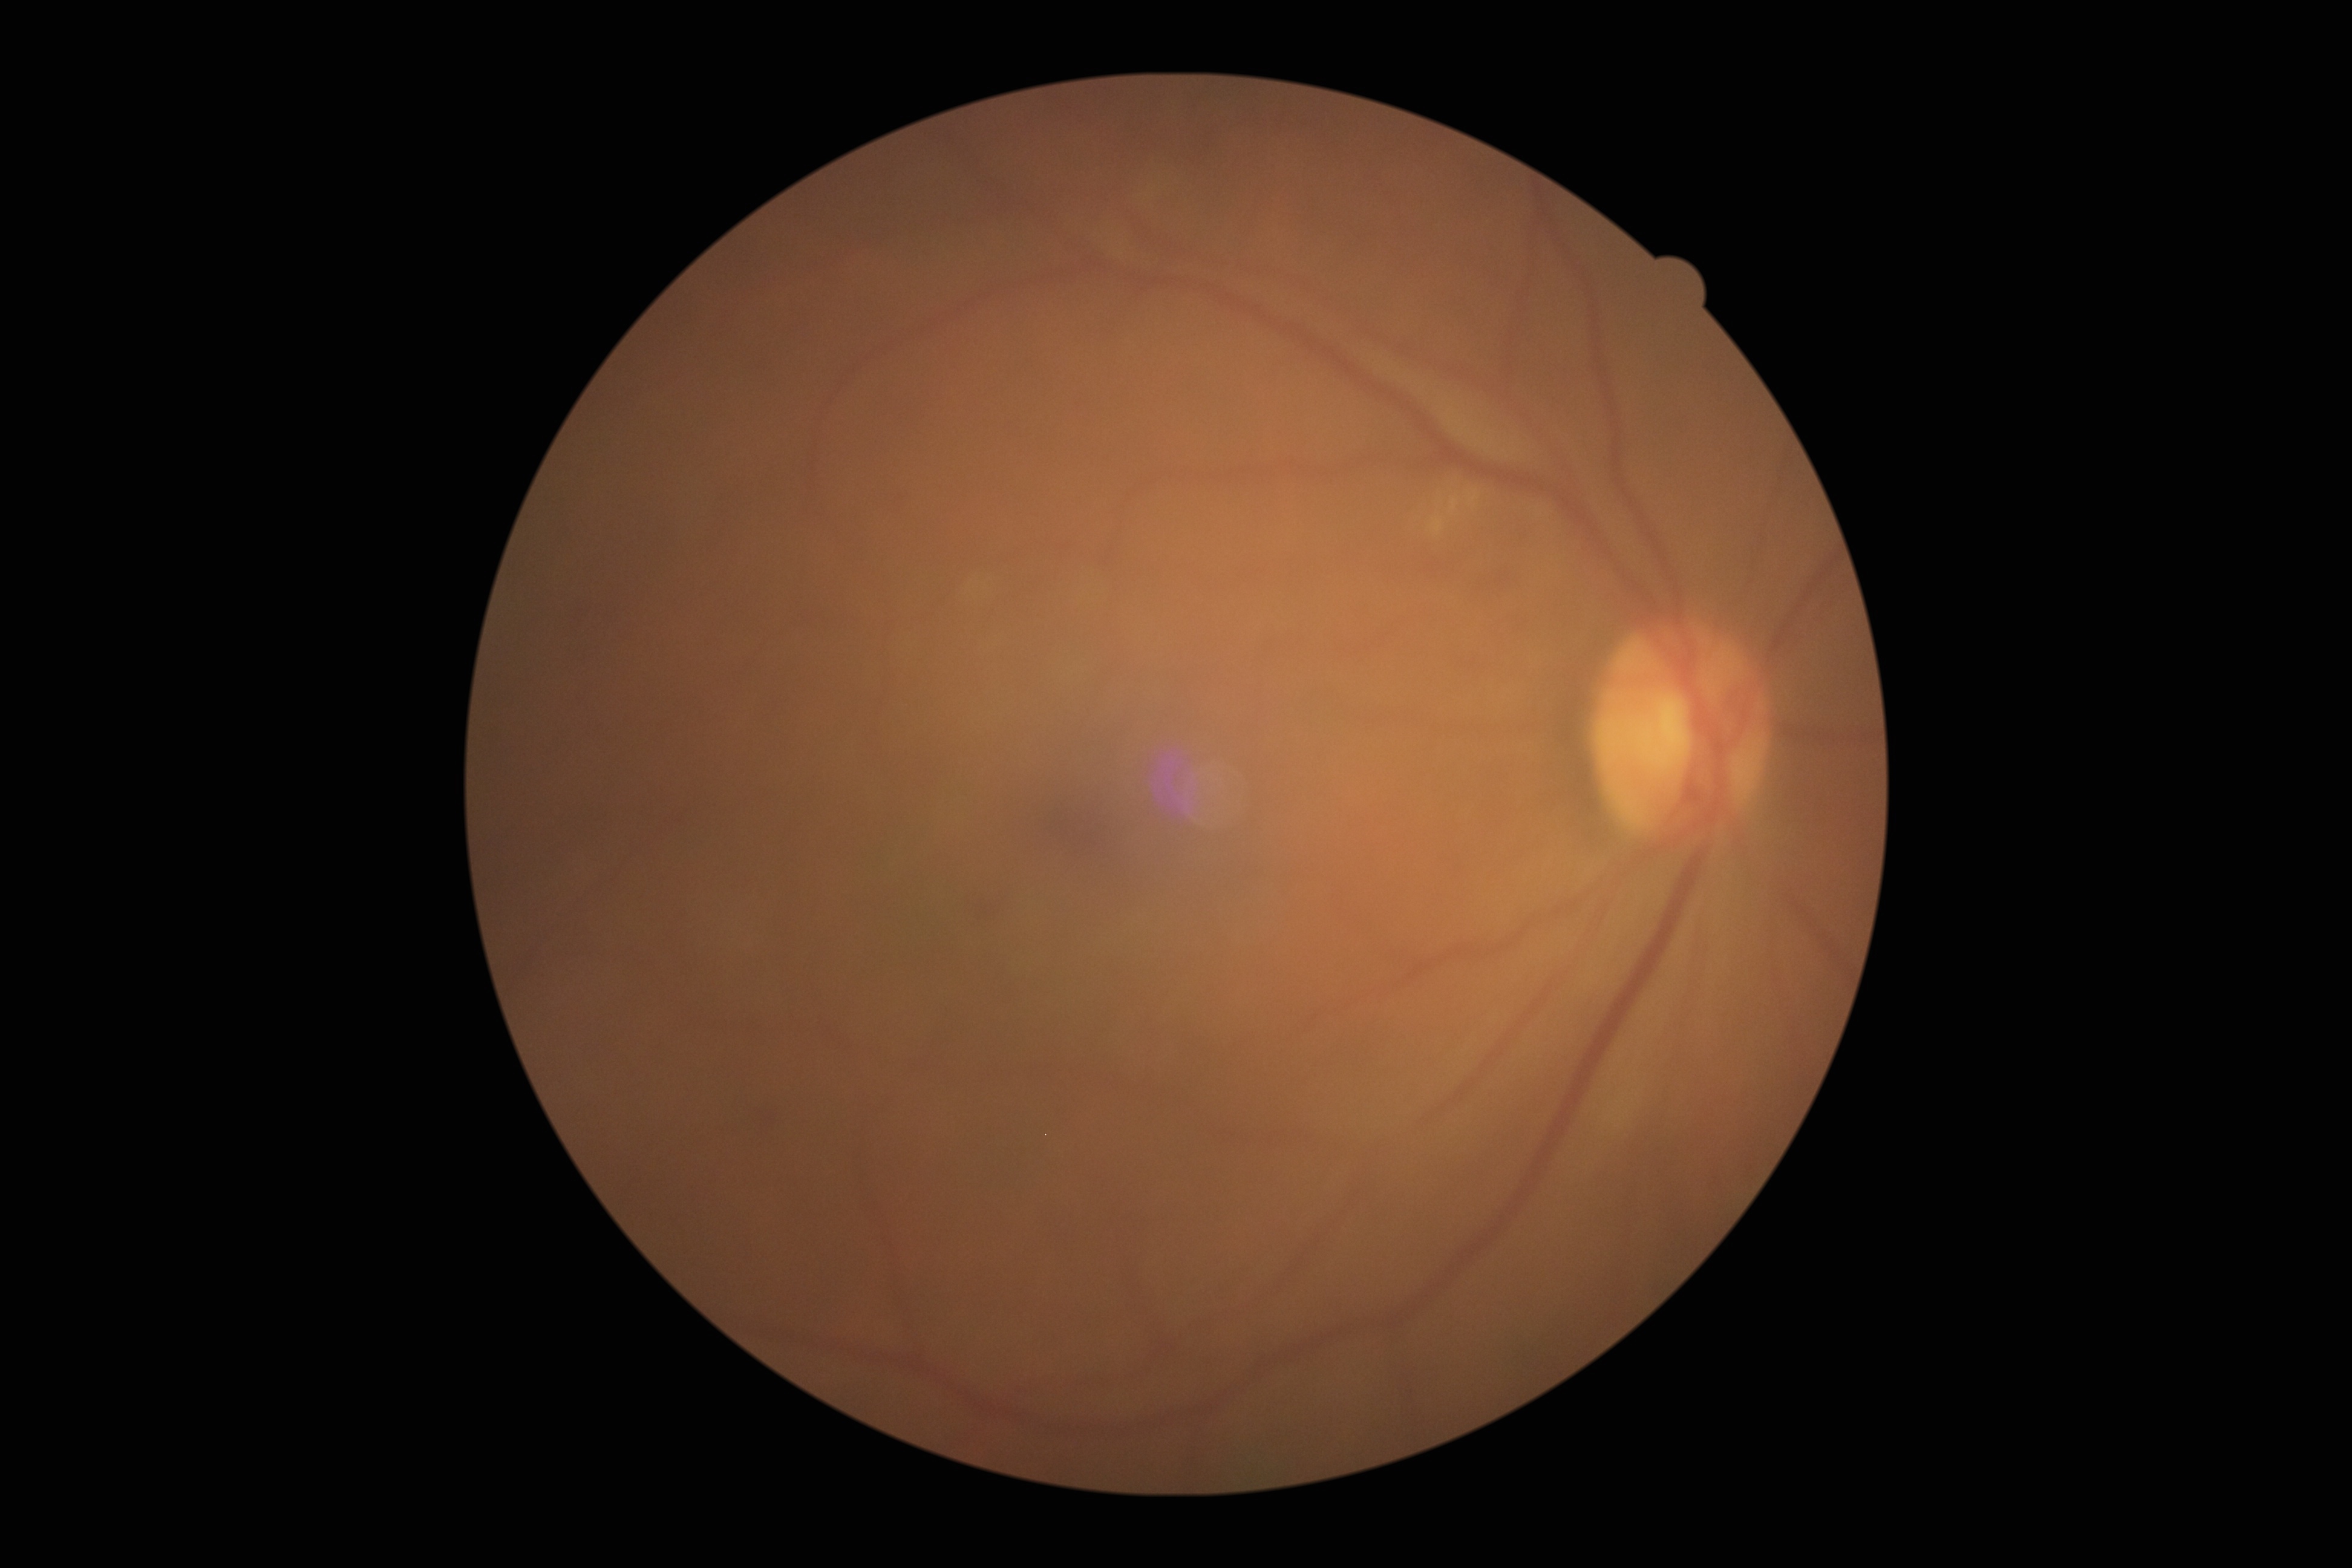

  dr_grade: grade 2 (moderate NPDR)